Fundus photo. 2048 x 1536 pixels: 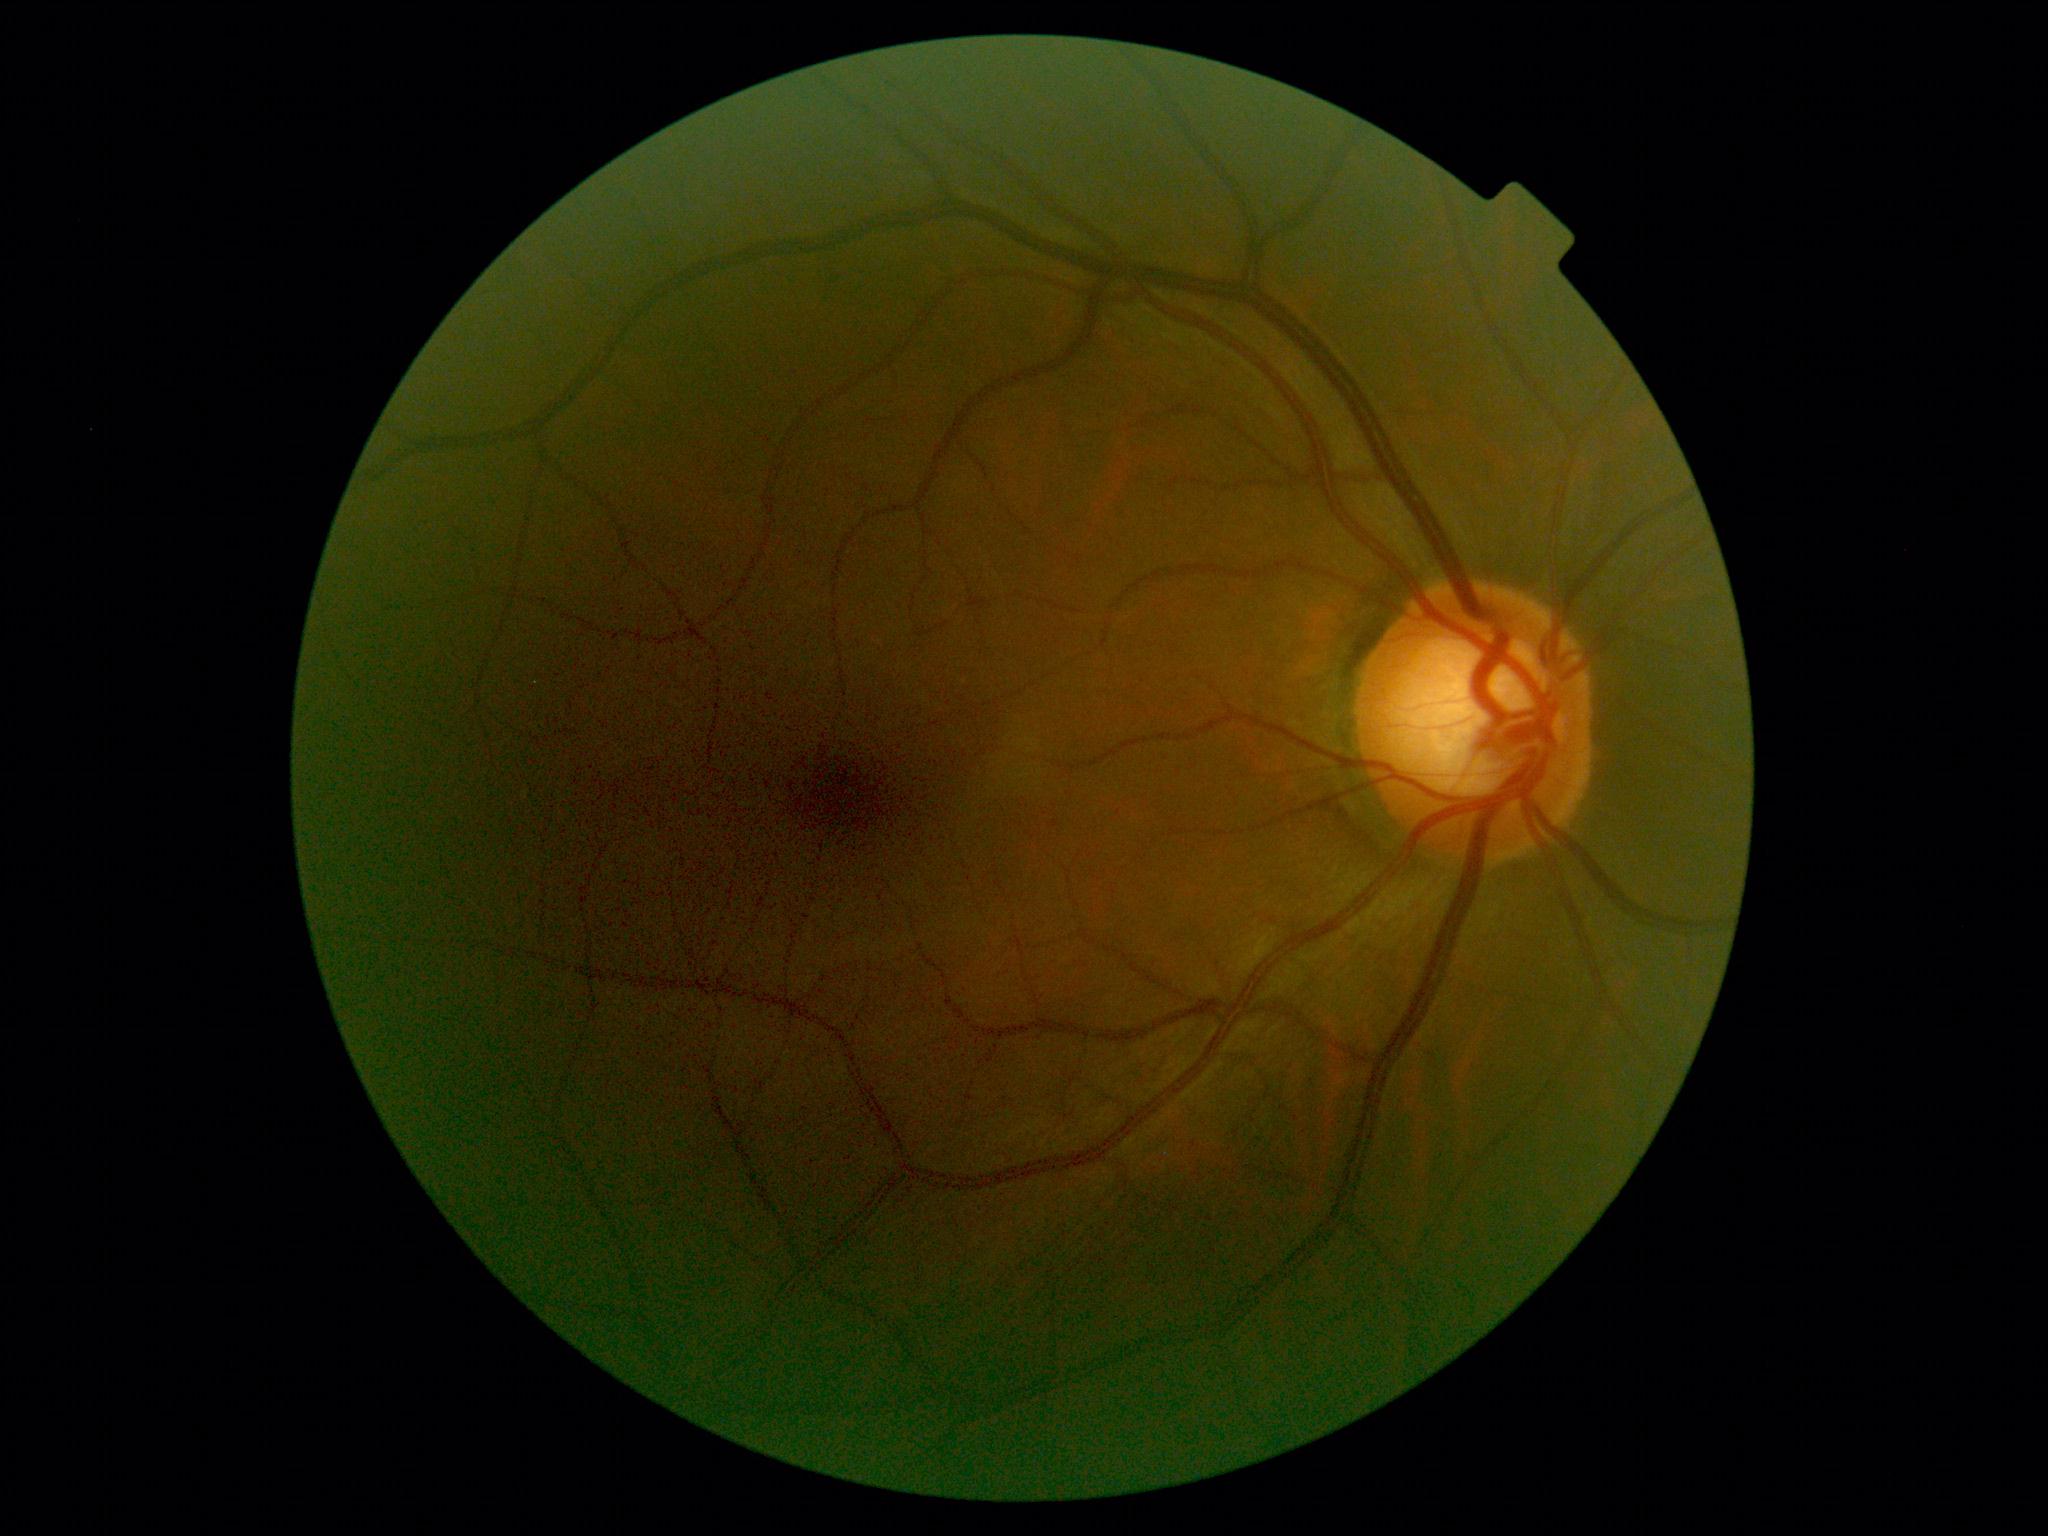
DR stage is grade 0 (no apparent retinopathy).